Macula at the center of the field; Kowa VX-10α; CFP; 50° FOV
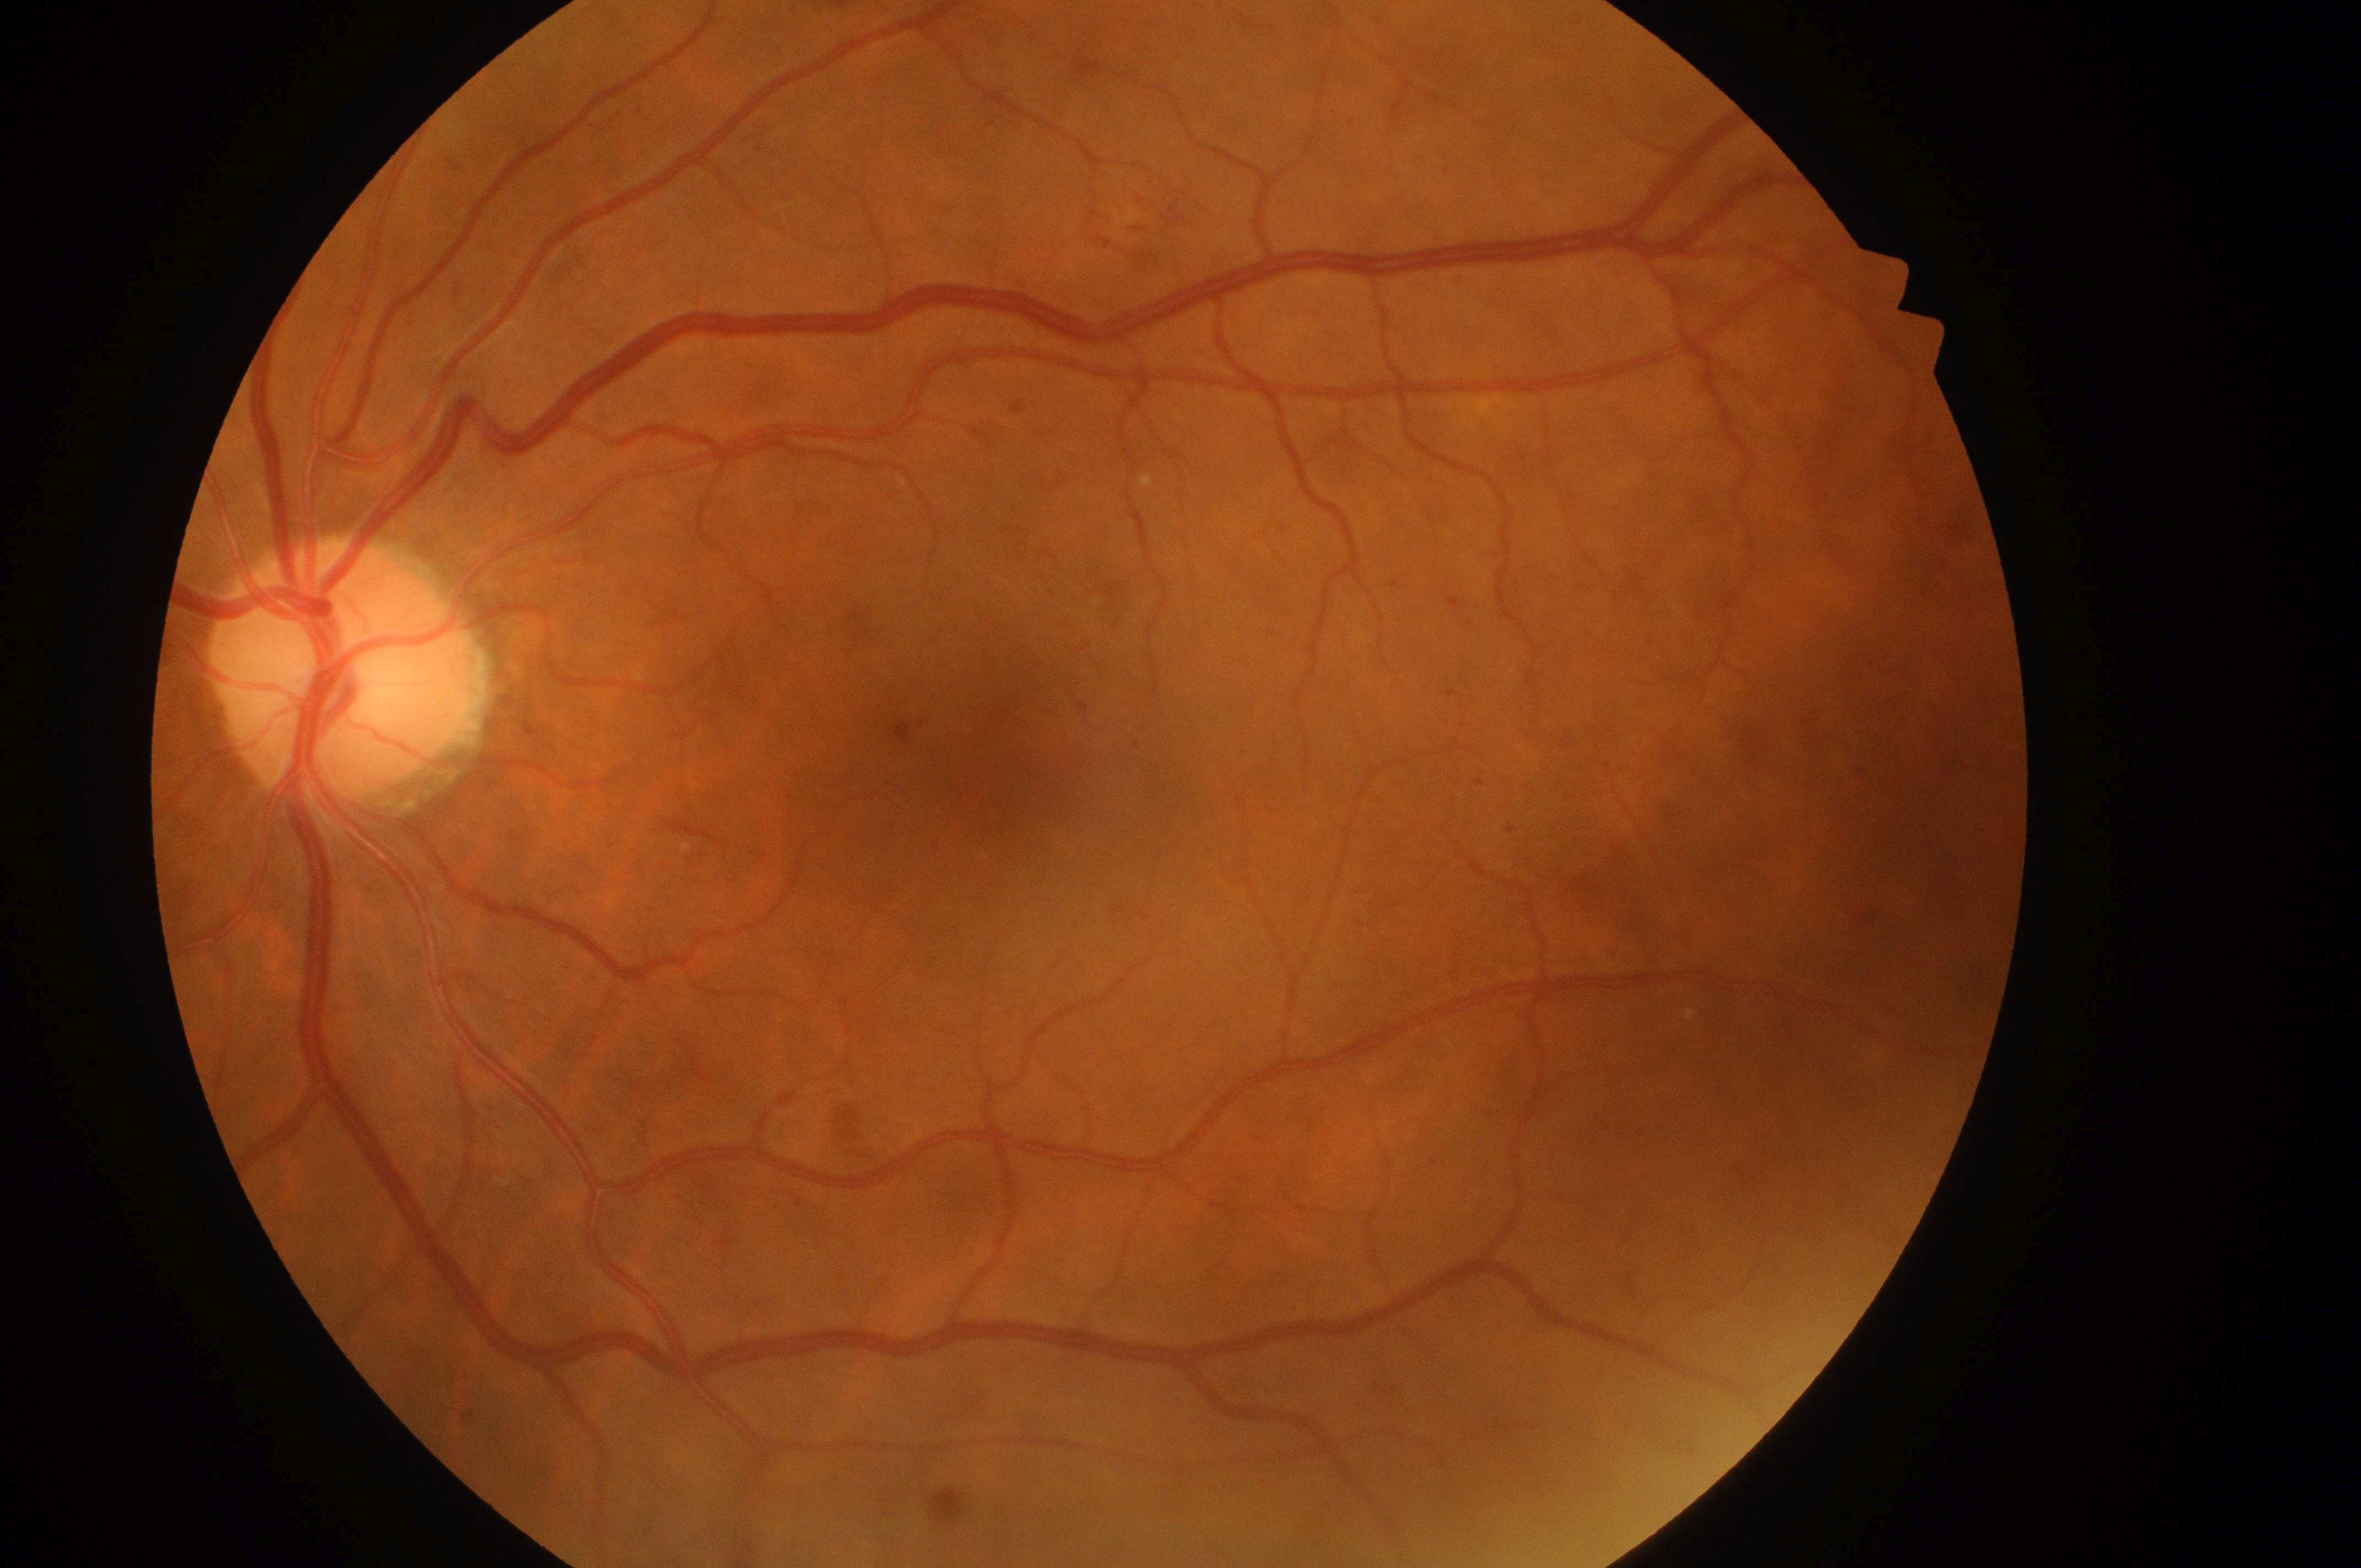 DME grade@2 (high risk); oculus sinister; optic nerve head@(x=338, y=678); foveal center@(x=992, y=777); DR grade@moderate NPDR (2).